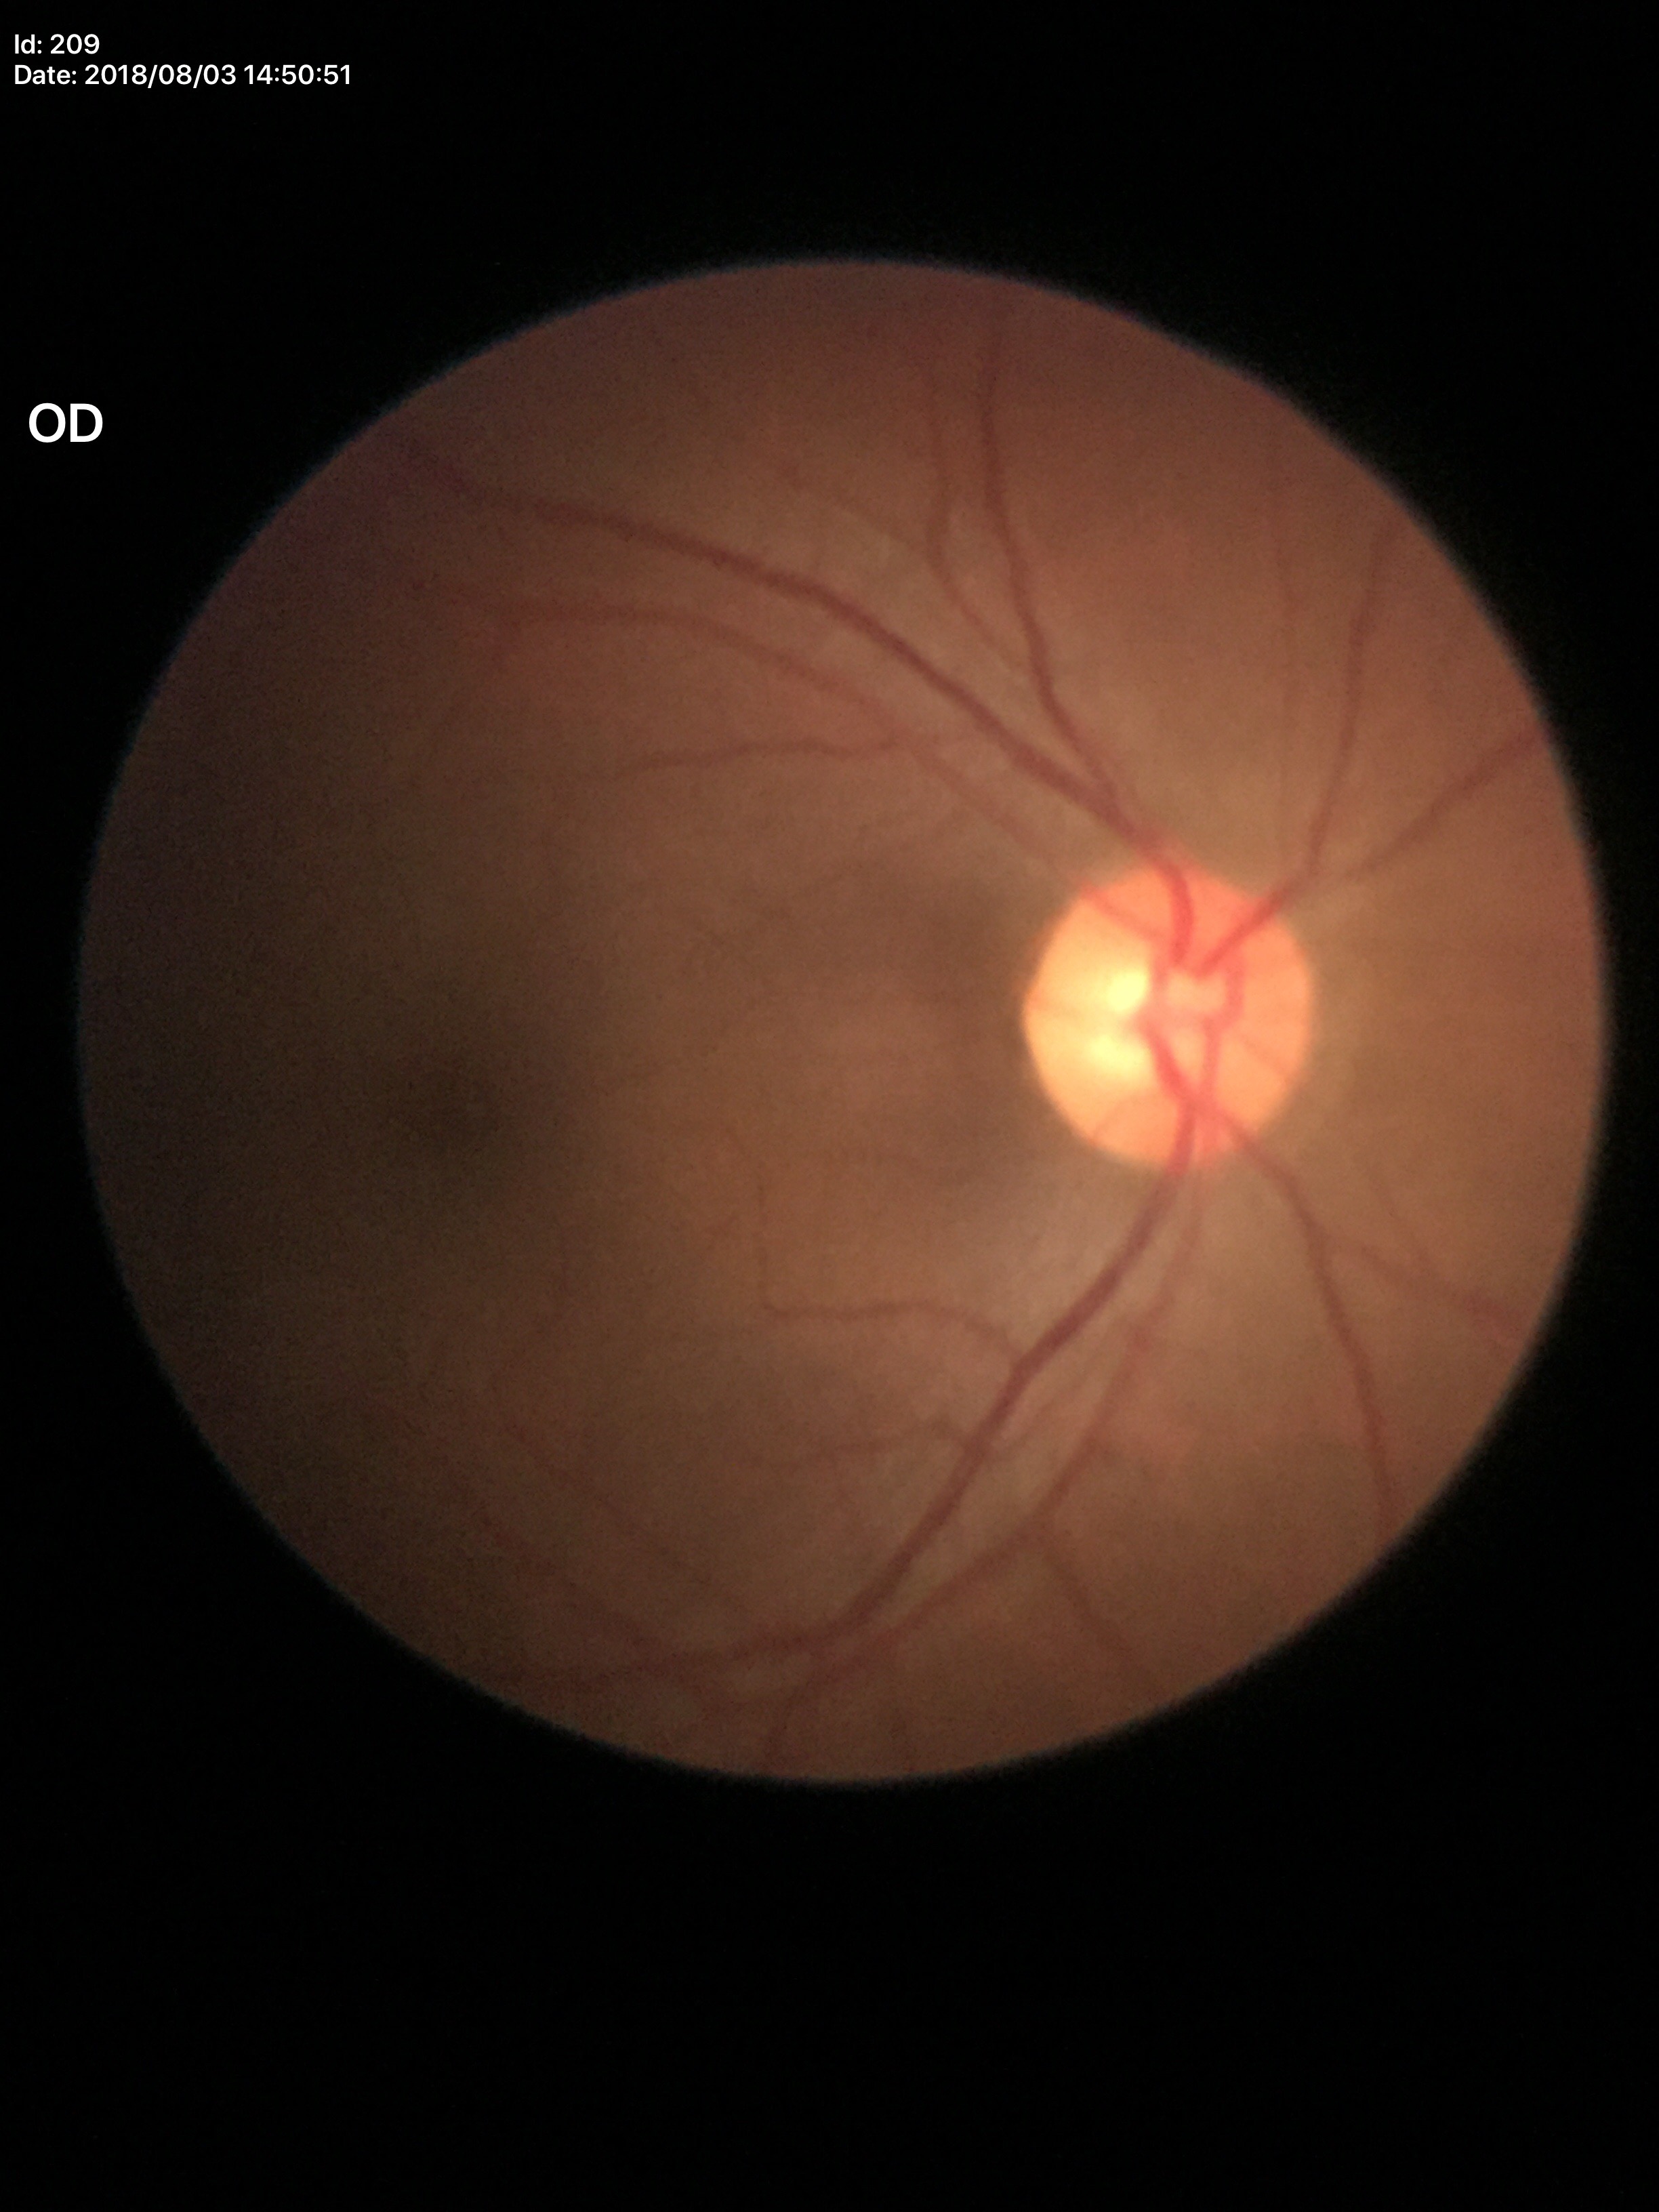

Glaucoma decision: not suspect (5/5 ophthalmologists in agreement); vertical CDR (VCDR): 0.49; horizontal cup-disc ratio (HCDR): 0.51.